Davis DR grading · posterior pole color fundus photograph · 848x848px · camera: NIDEK AFC-230 · no pharmacologic dilation — 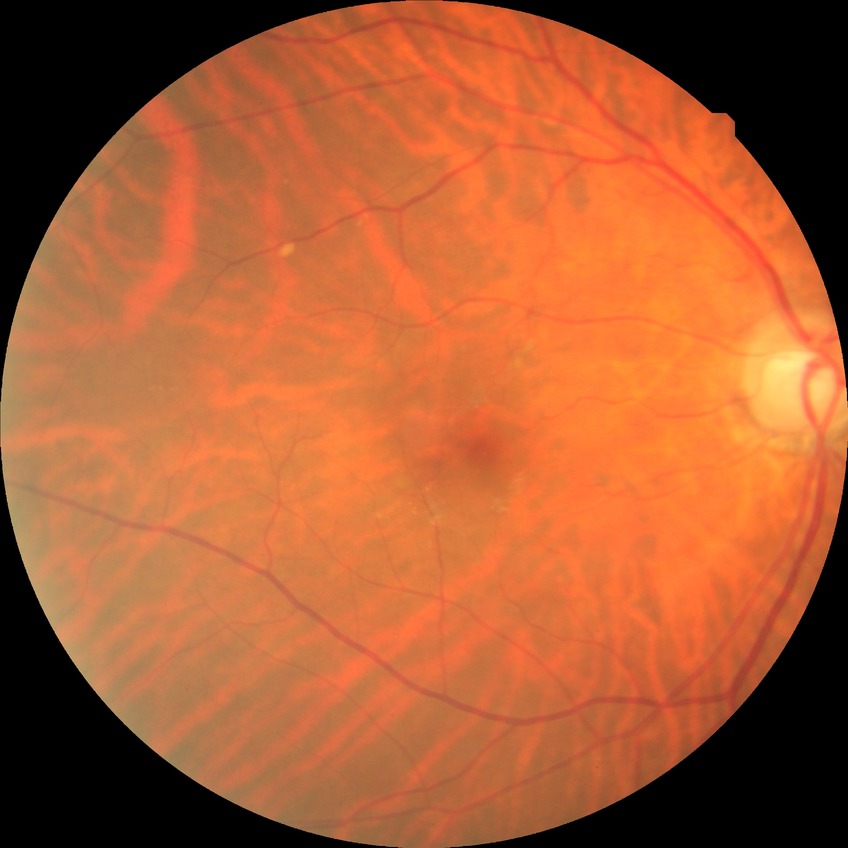 Modified Davis grading: no diabetic retinopathy.